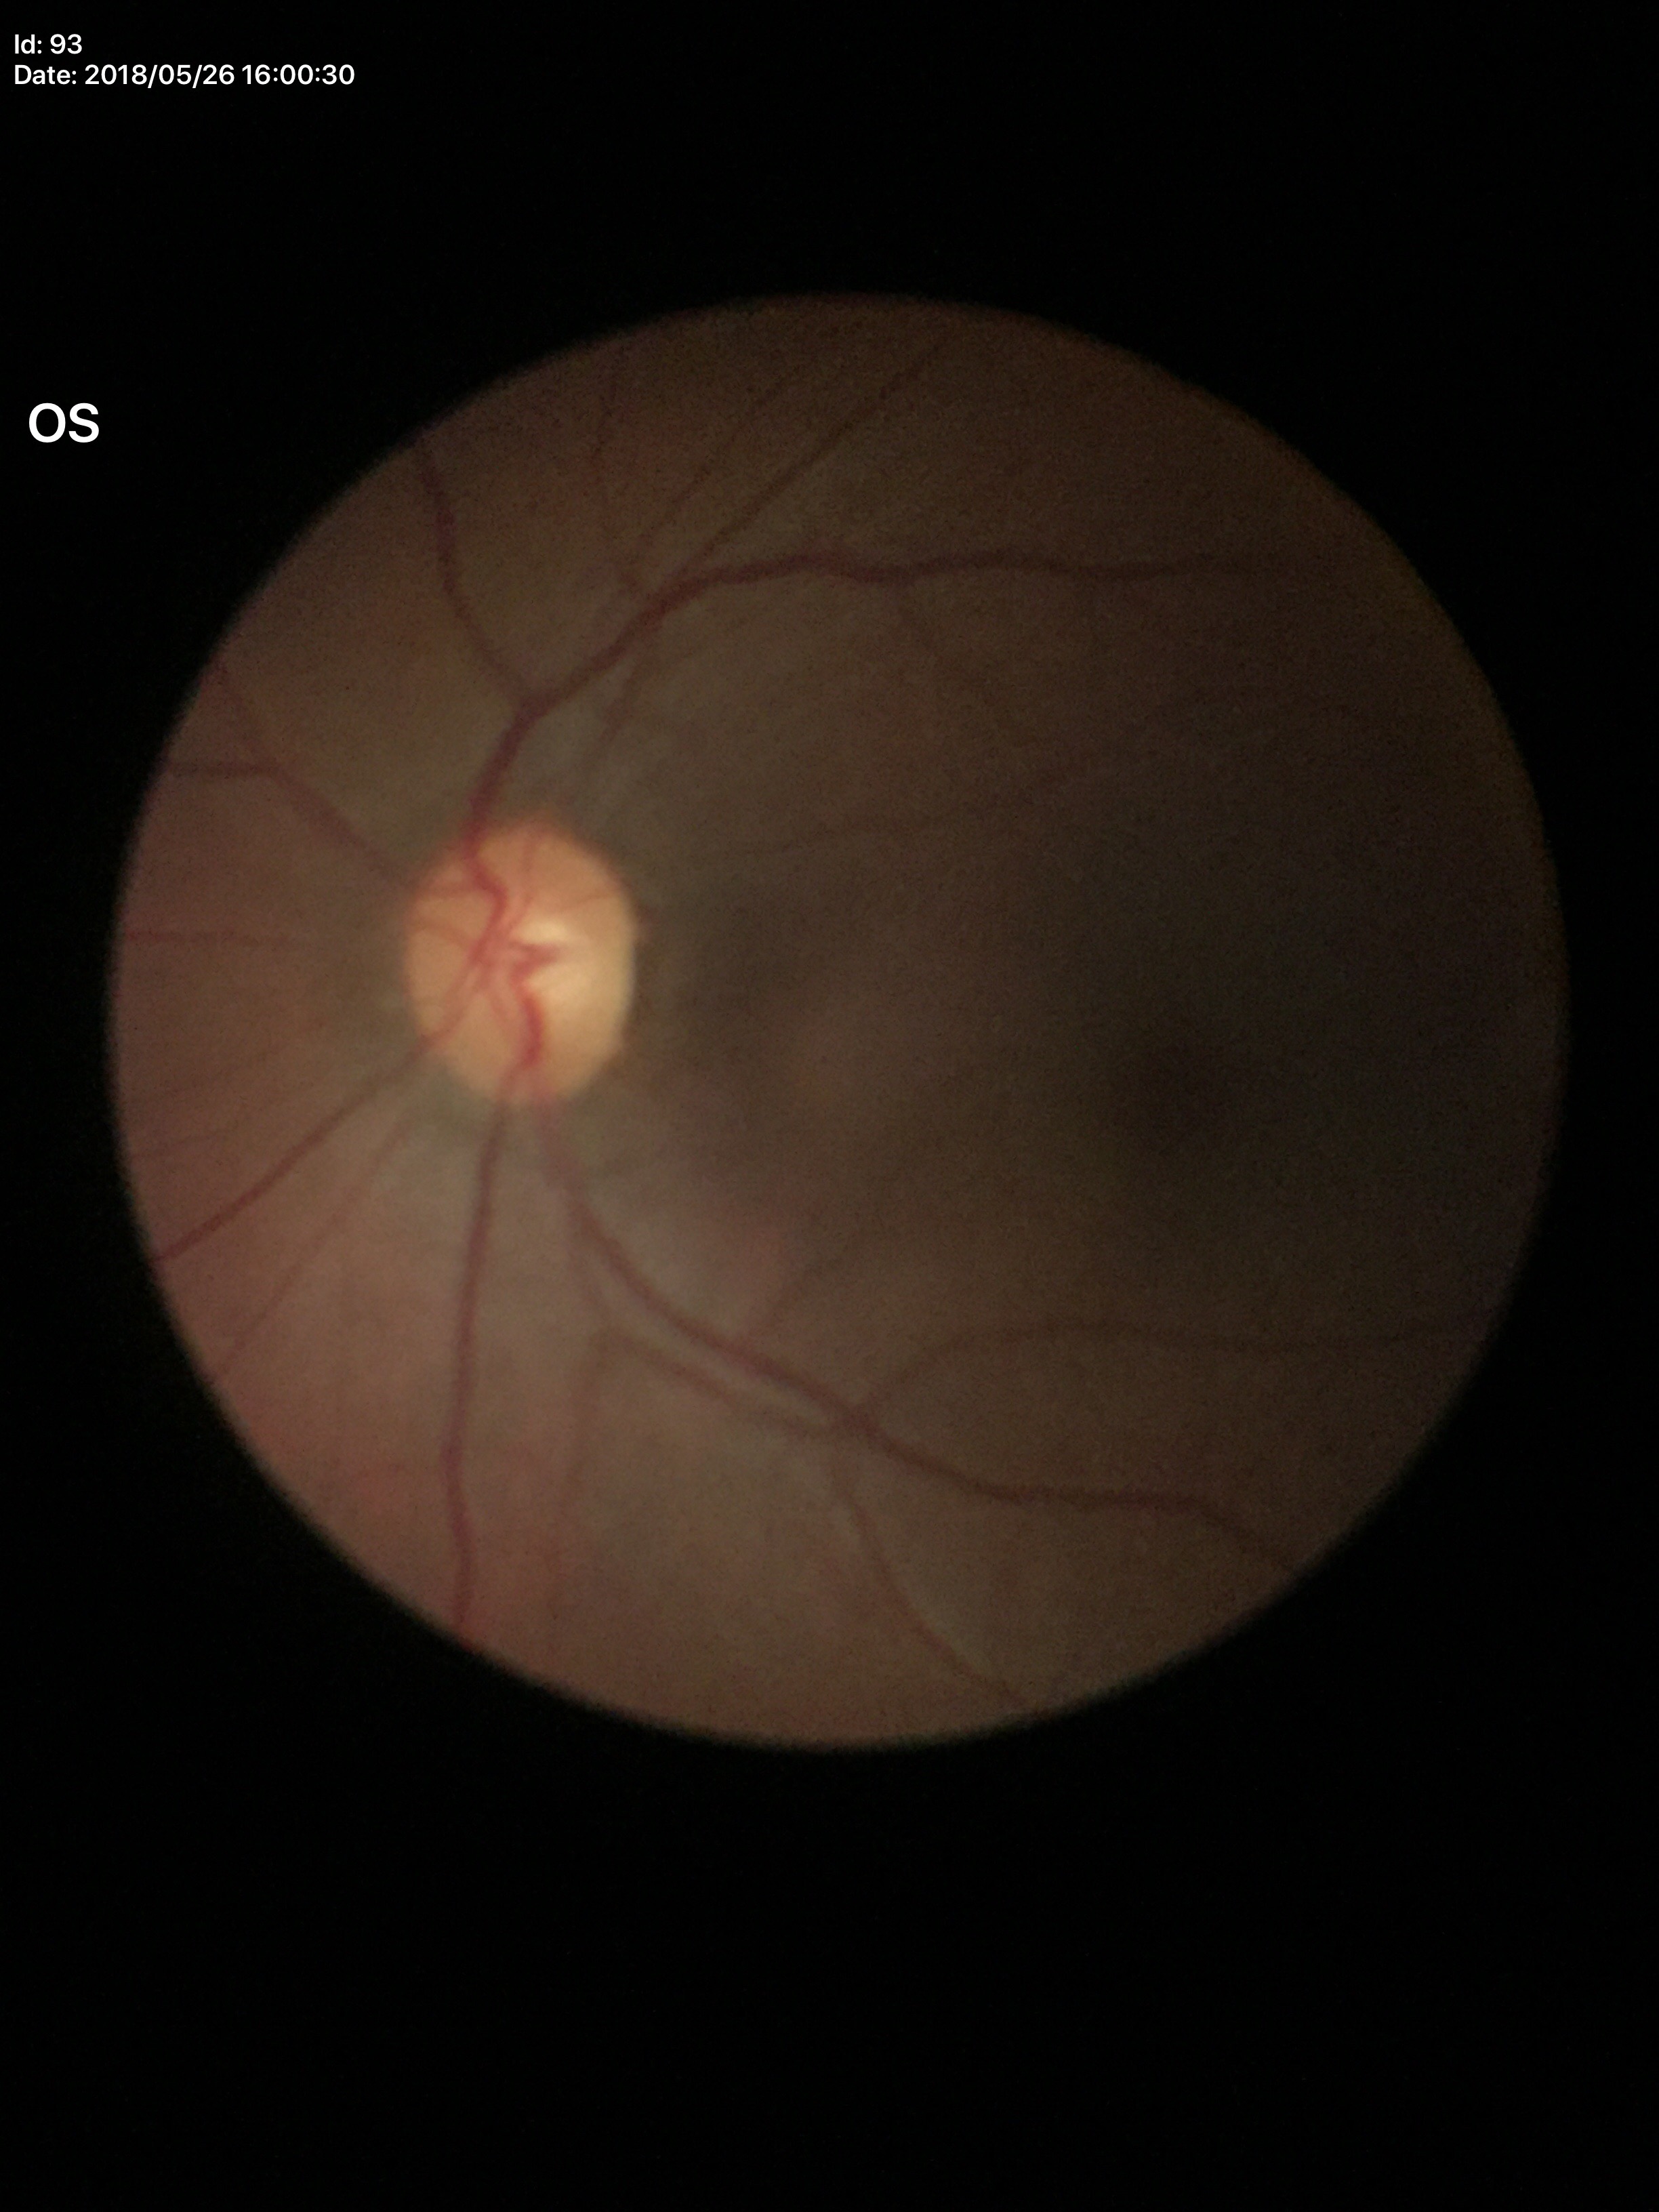

No glaucomatous findings (5/5 ophthalmologists in agreement). Vertical cup-disc ratio (VCDR) is 0.53. Horizontal cup-to-disc ratio (HCDR) is 0.54.